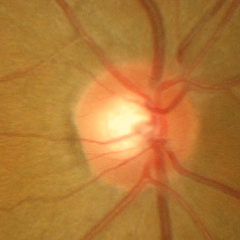

Glaucoma diagnosis = no signs of glaucoma.